Acquired with a NIDEK AFC-230. 848 by 848 pixels. DR severity per modified Davis staging
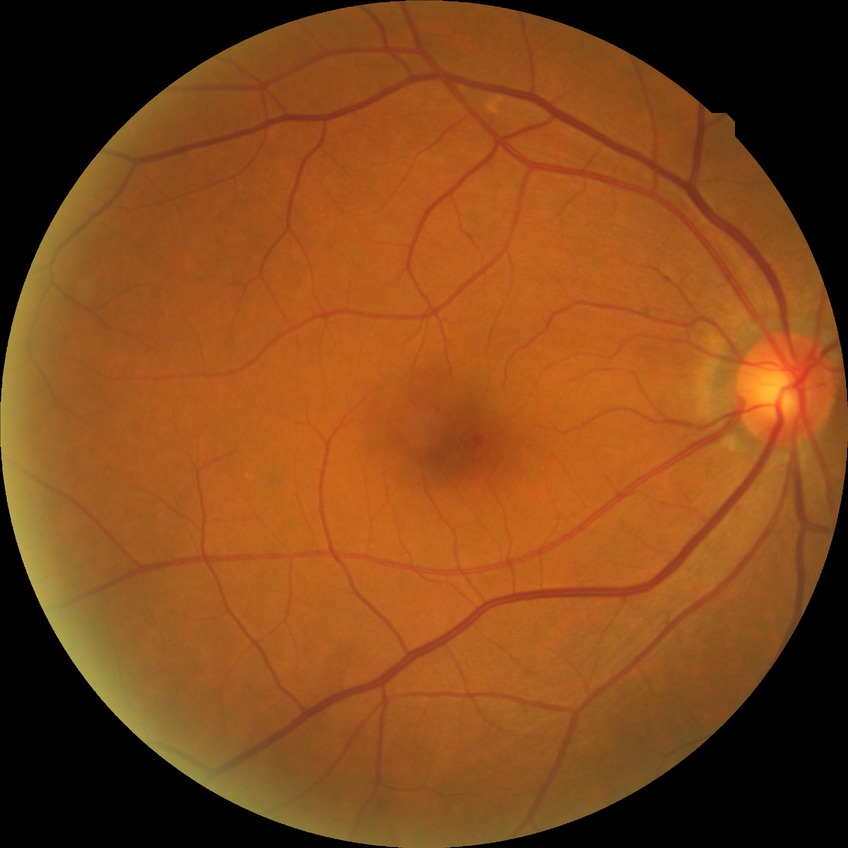
diabetic retinopathy (DR) = no diabetic retinopathy (NDR).